2352x1568px — 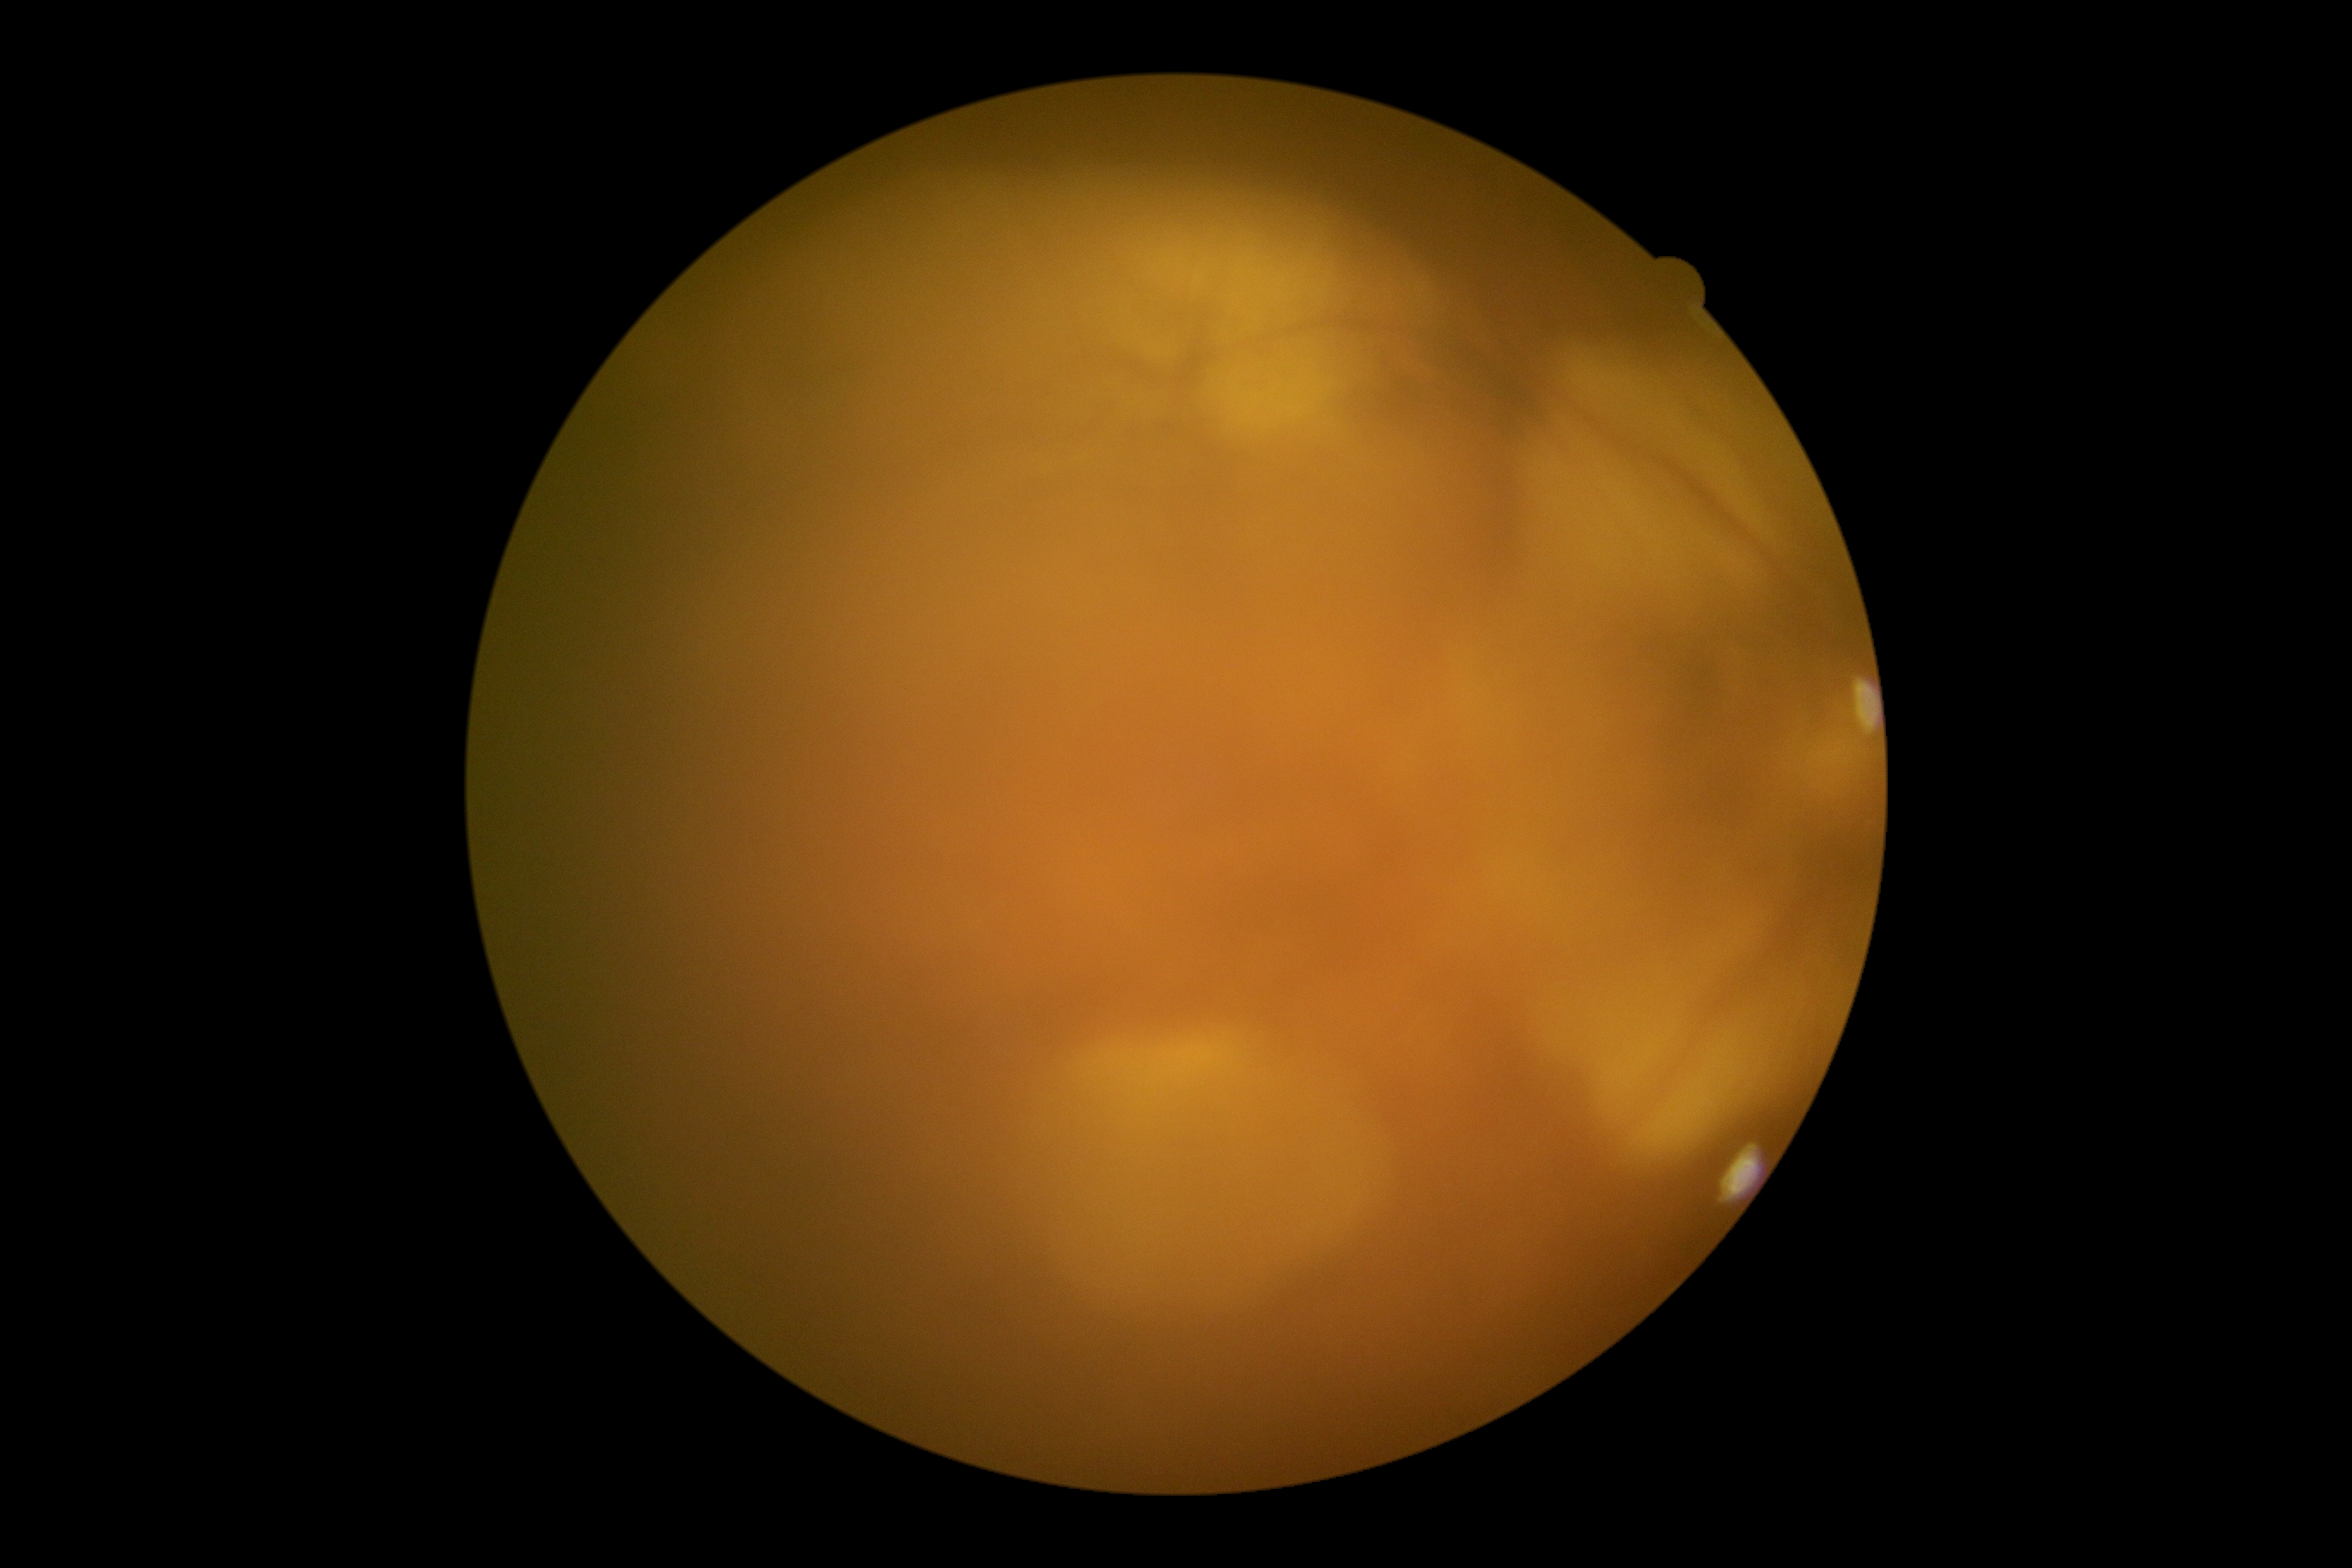 The image cannot be graded for diabetic retinopathy.
Diabetic retinopathy is ungradable.